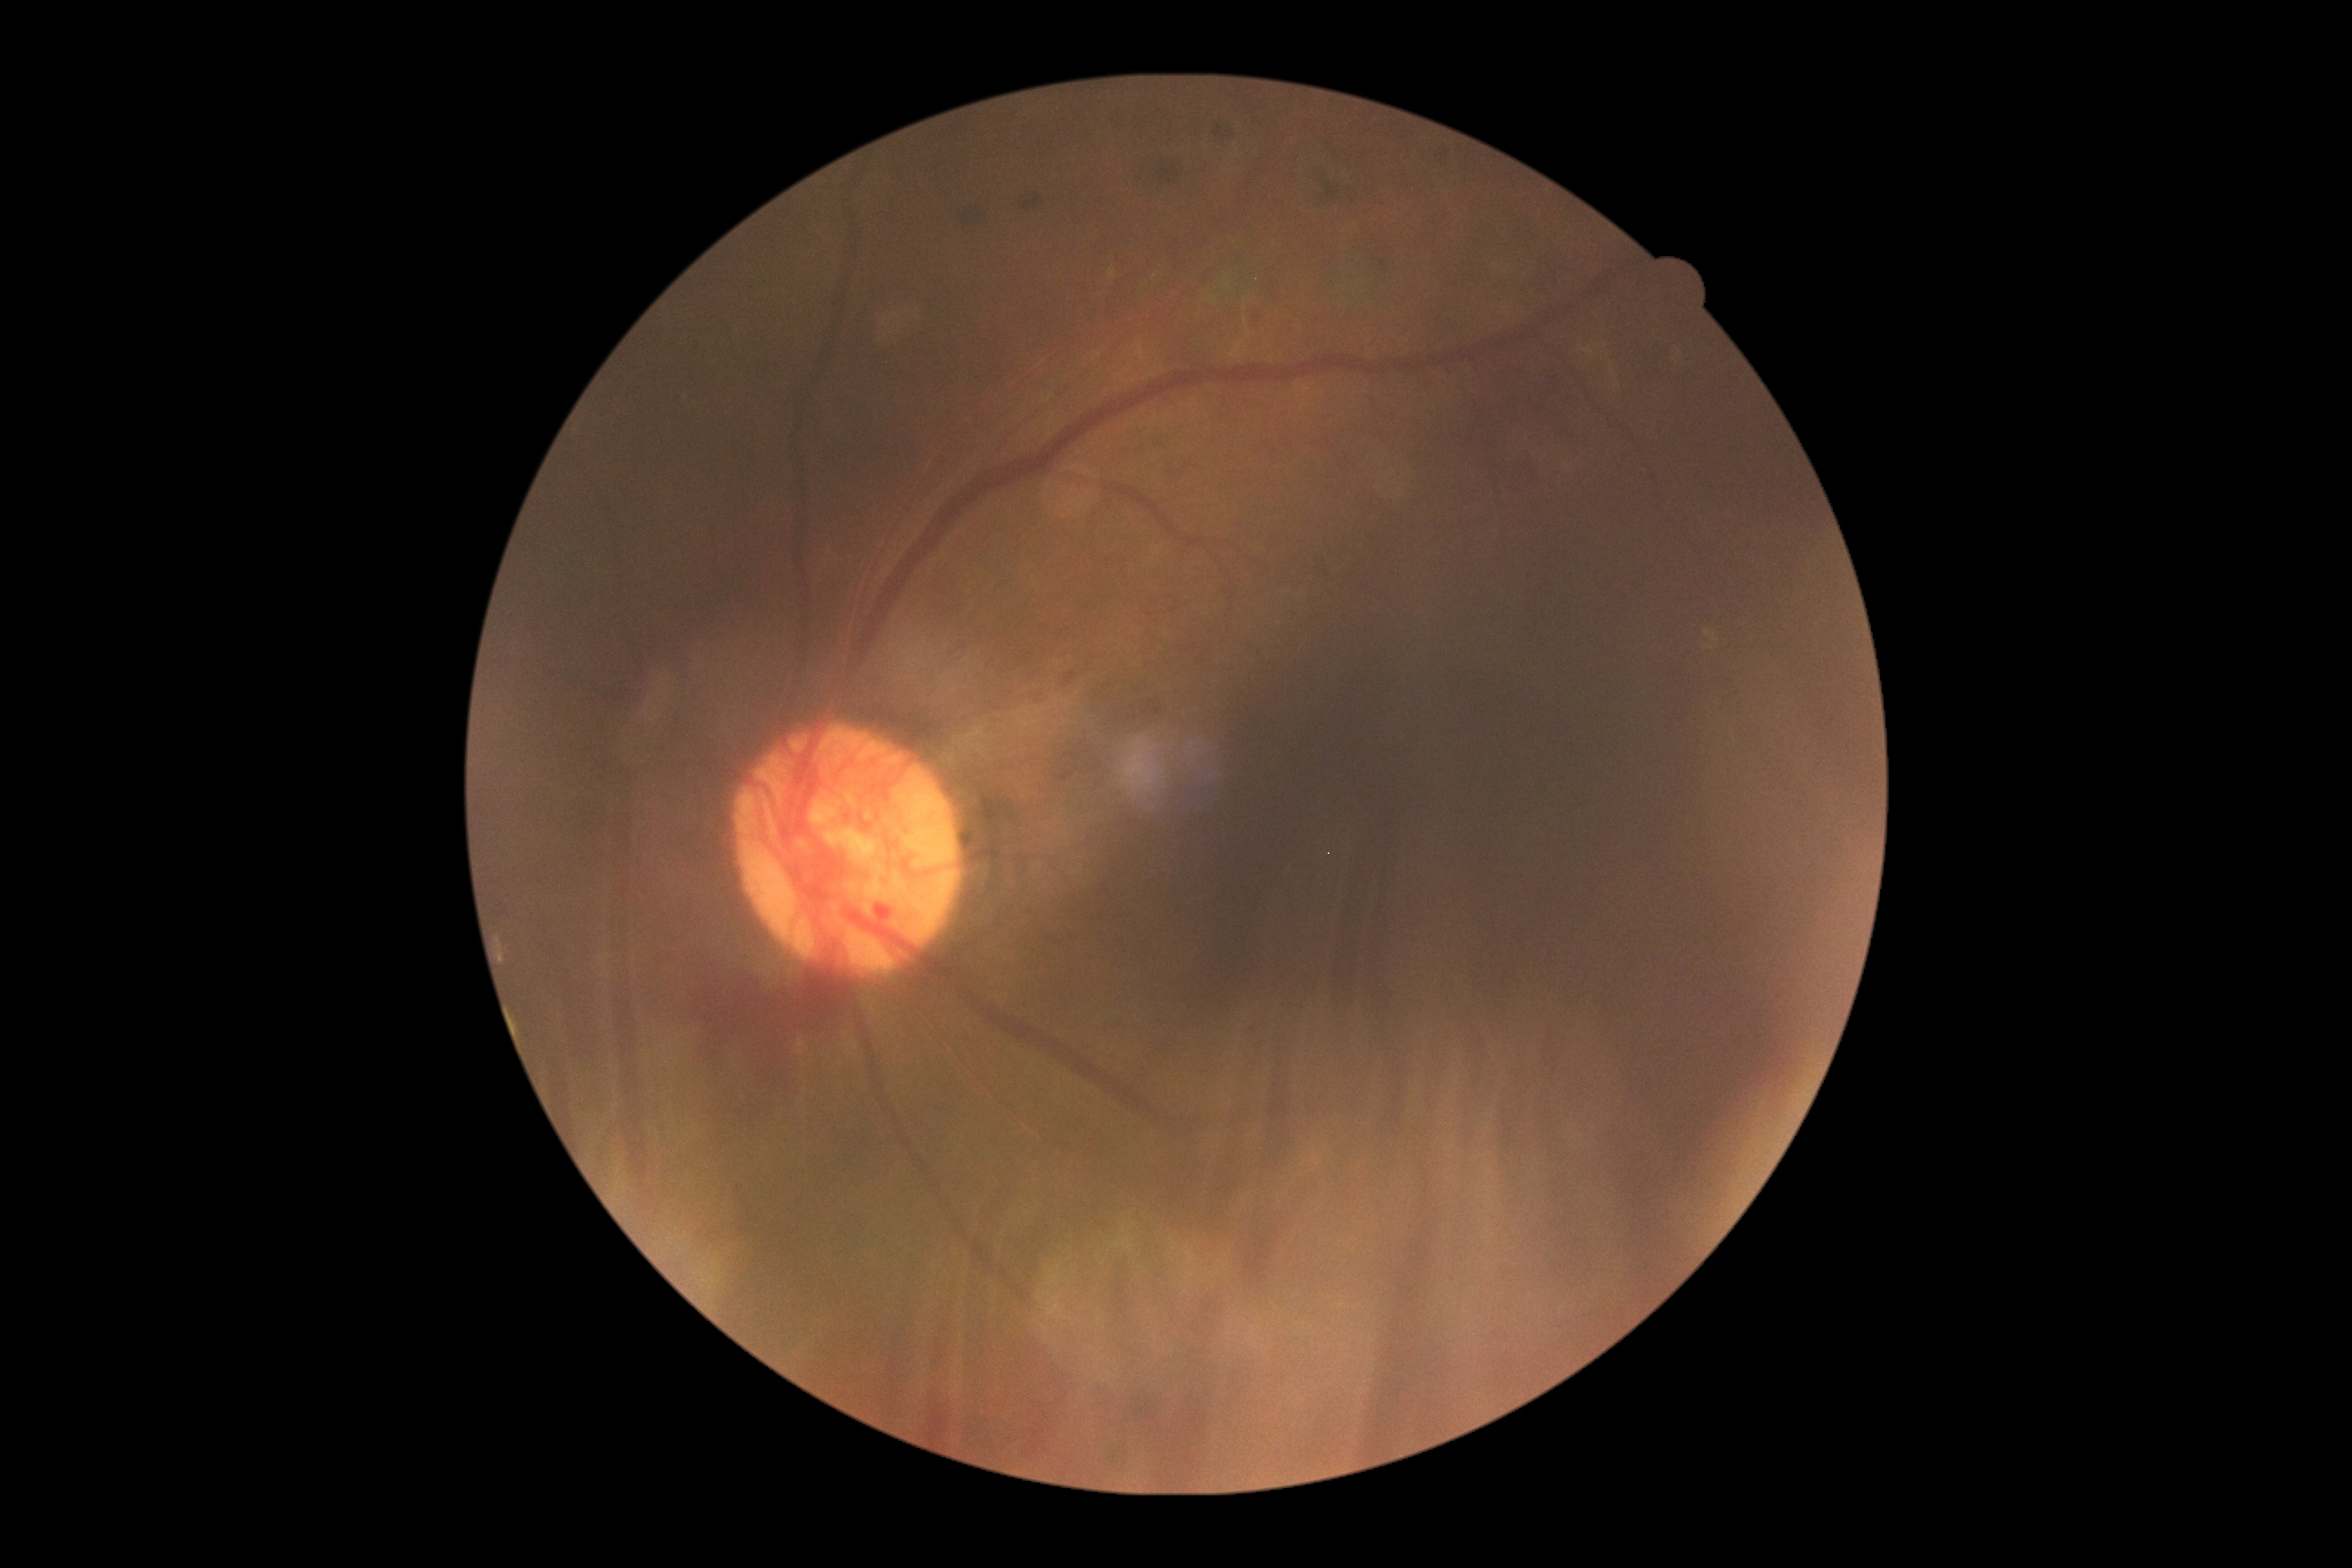 DR: proliferative diabetic retinopathy (grade 4). Disease class: proliferative diabetic retinopathy.